Infant wide-field fundus photograph; acquired on the Clarity RetCam 3: 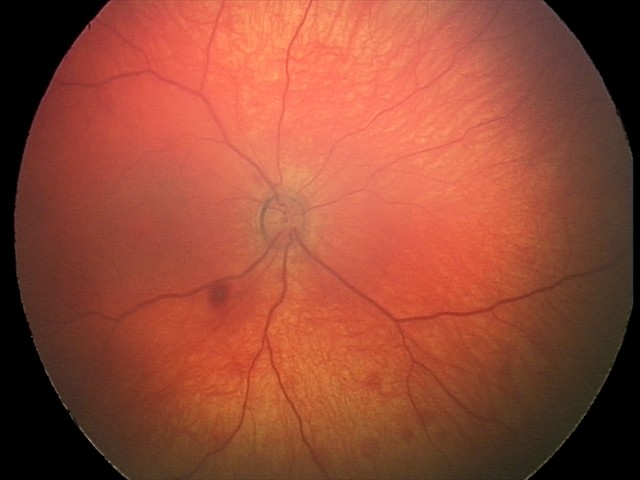 Examination diagnosed as retinal hemorrhages.